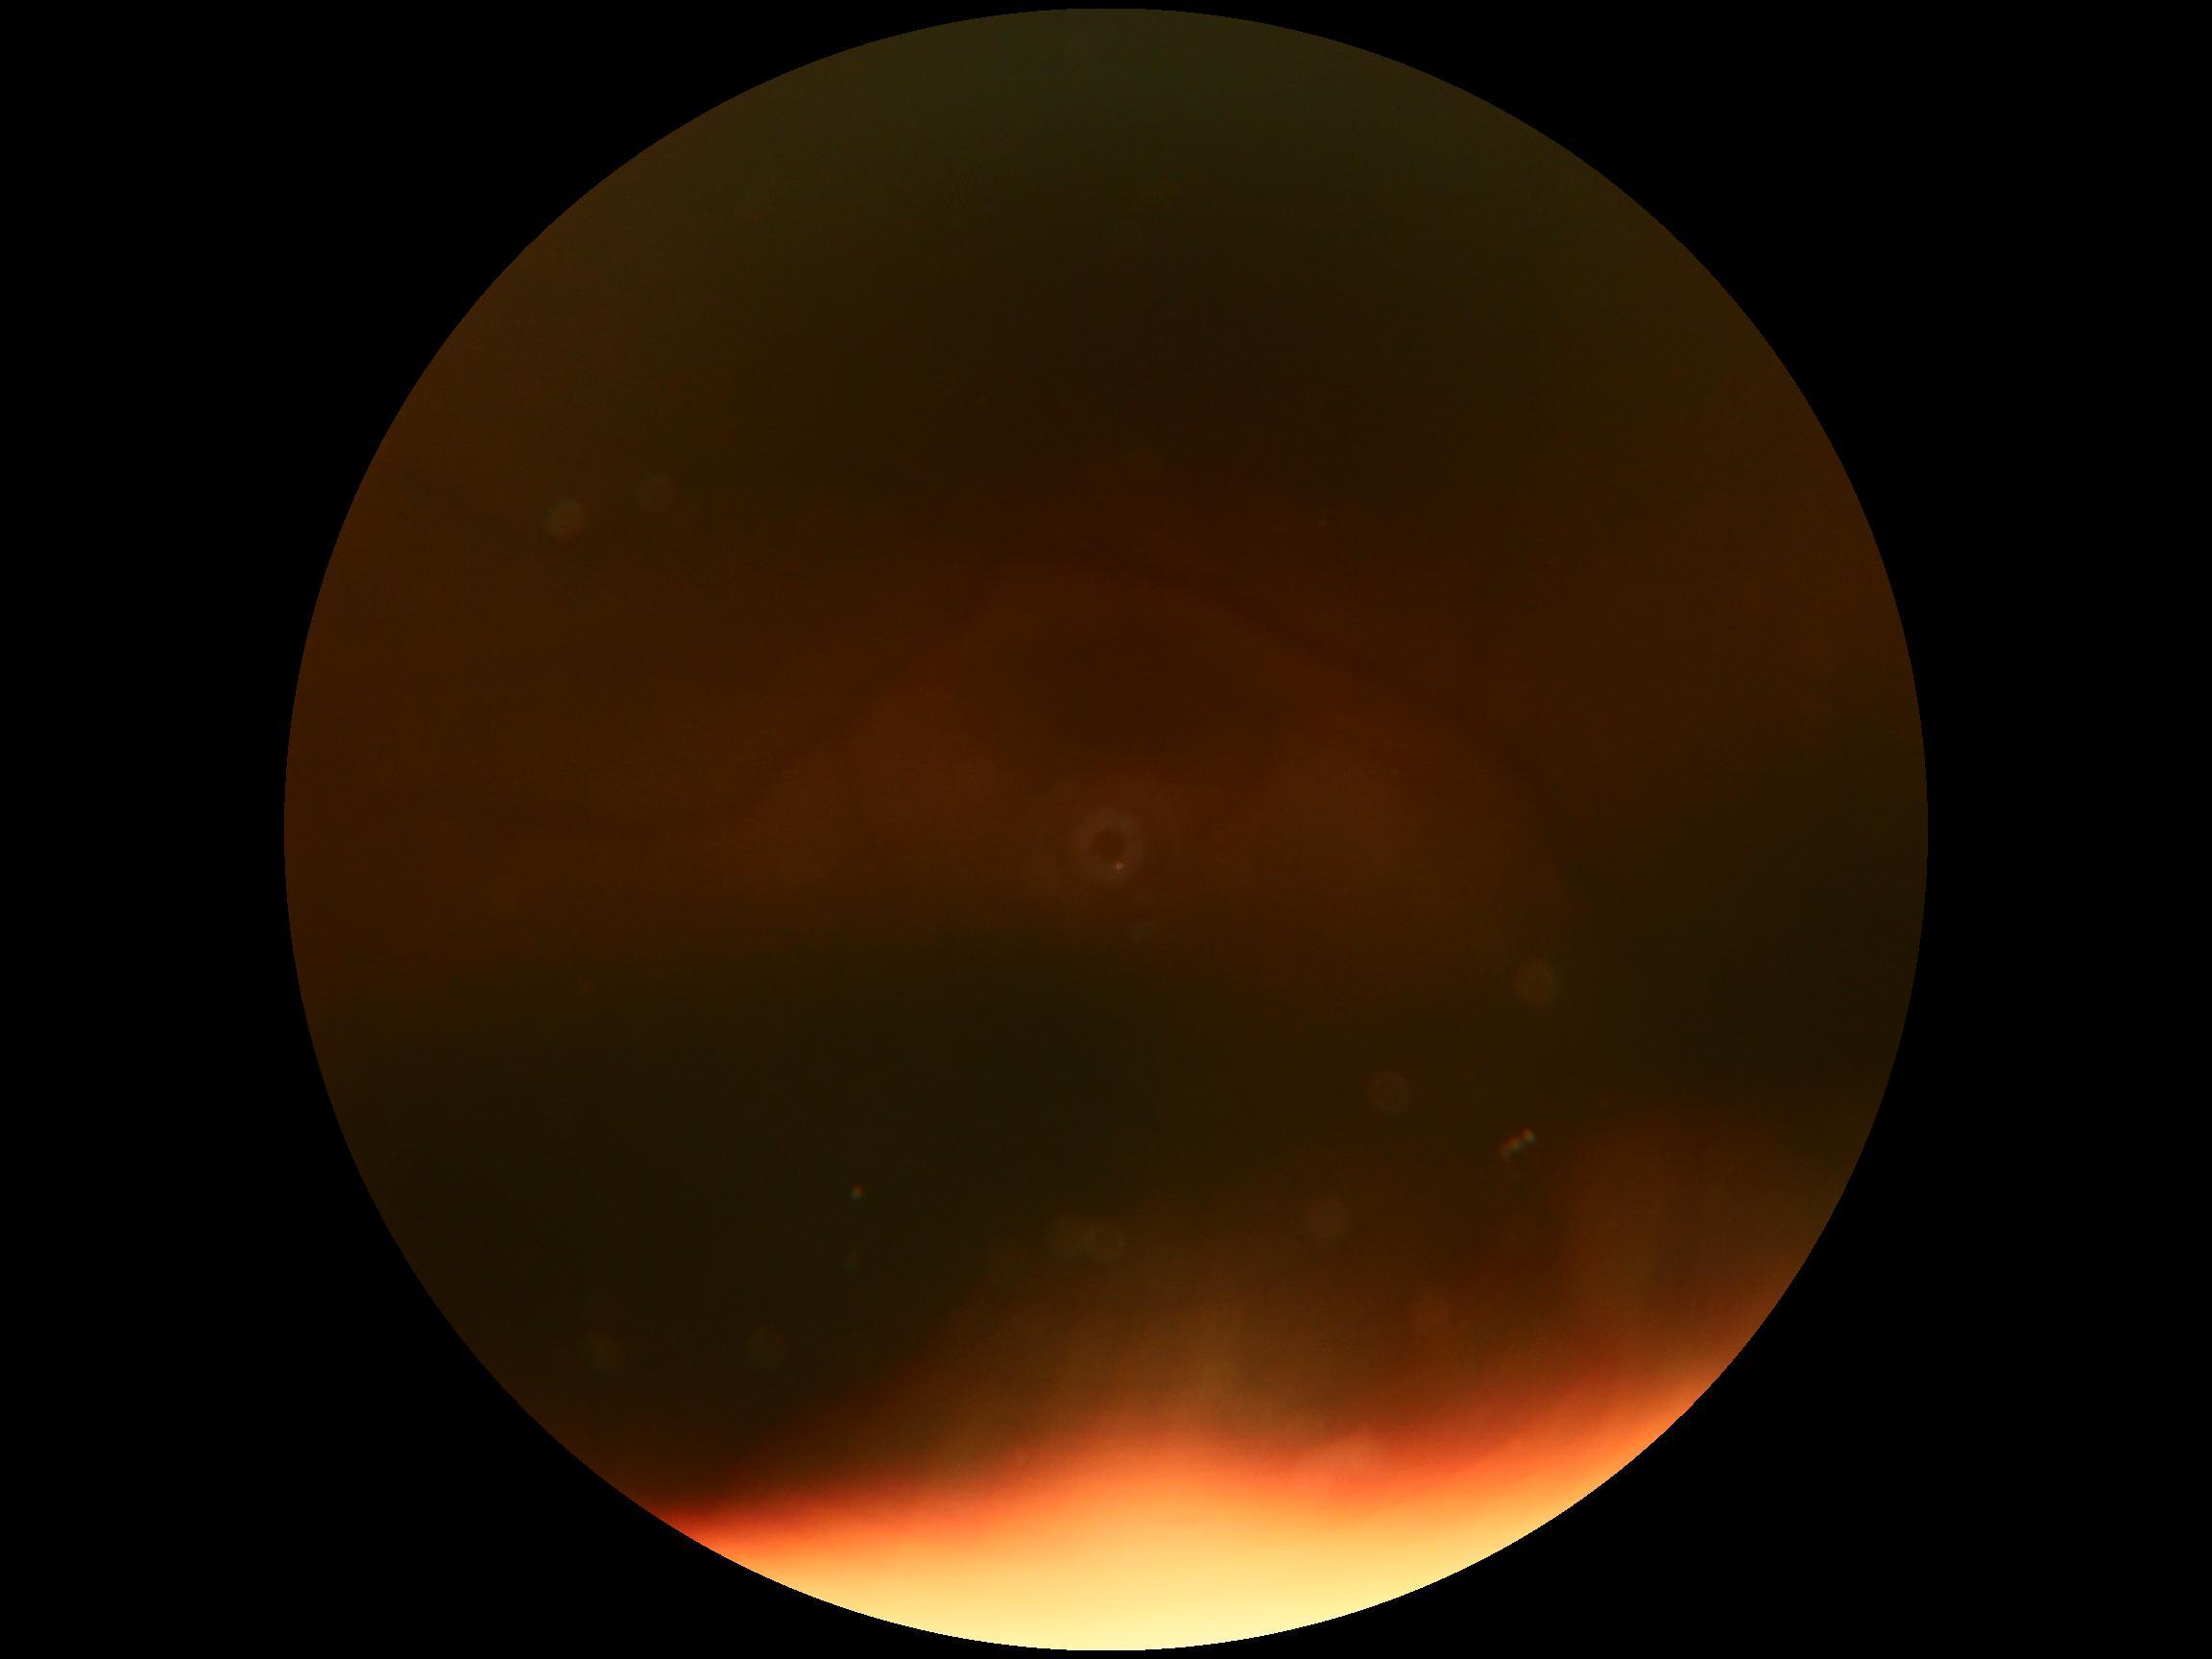 Ungradable image — DR severity cannot be determined.
DR: ungradable.